Pediatric retinal photograph (wide-field); 1240x1240:
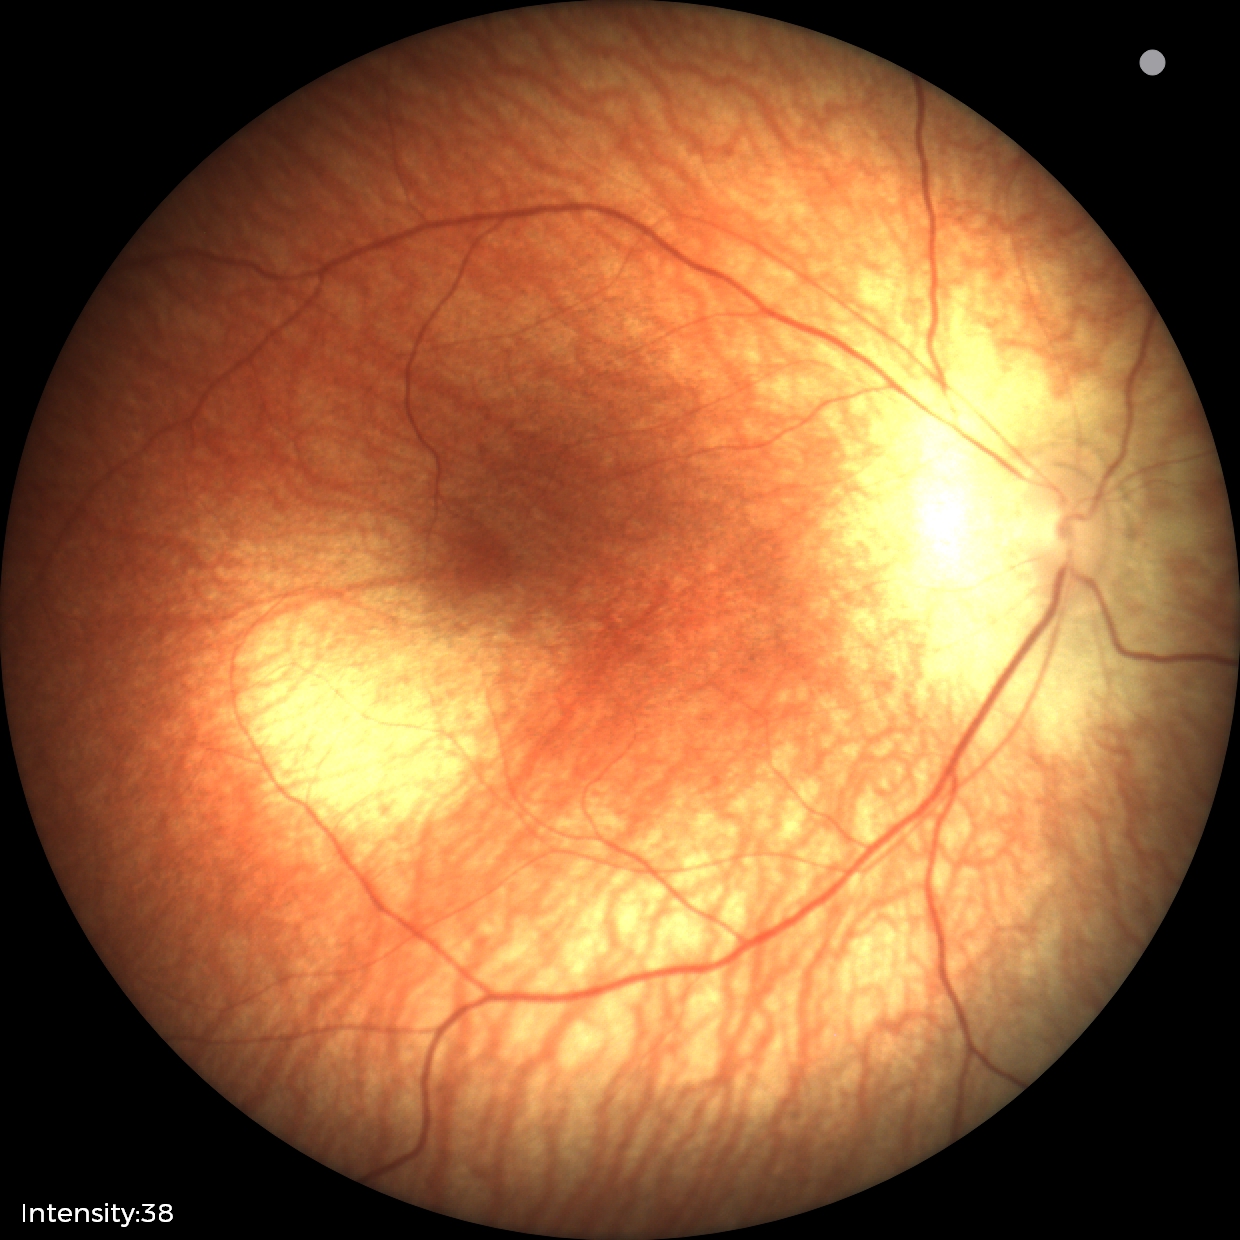 Physiological retinal appearance for postconceptual age.